848x848px: 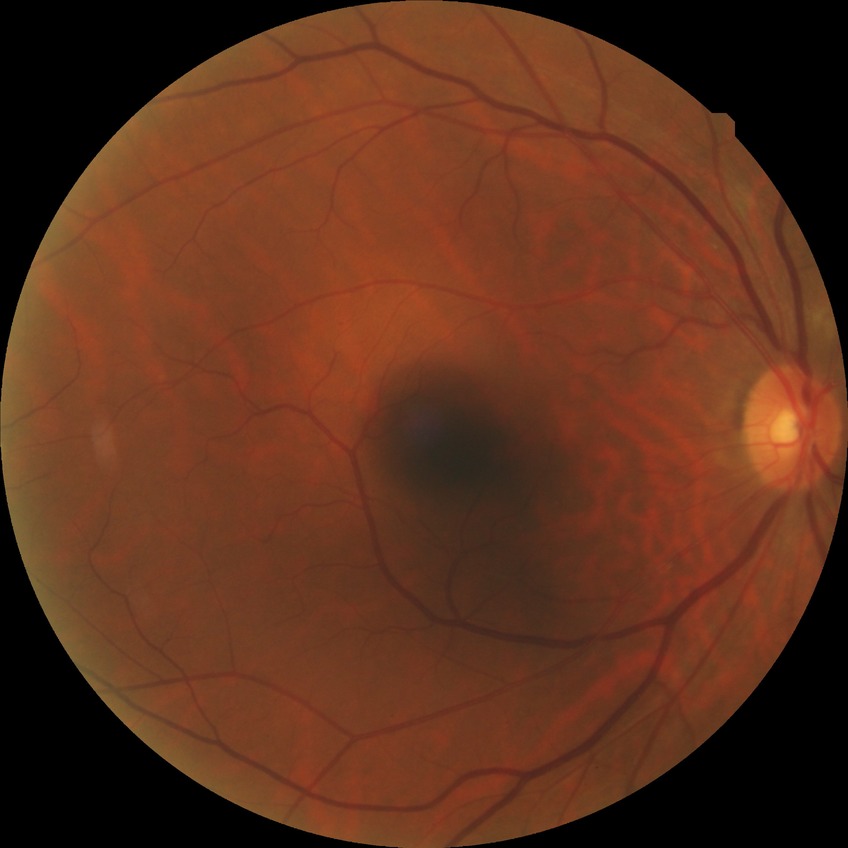

diabetic retinopathy (DR) = NDR (no diabetic retinopathy).